2352 x 1568 pixels: 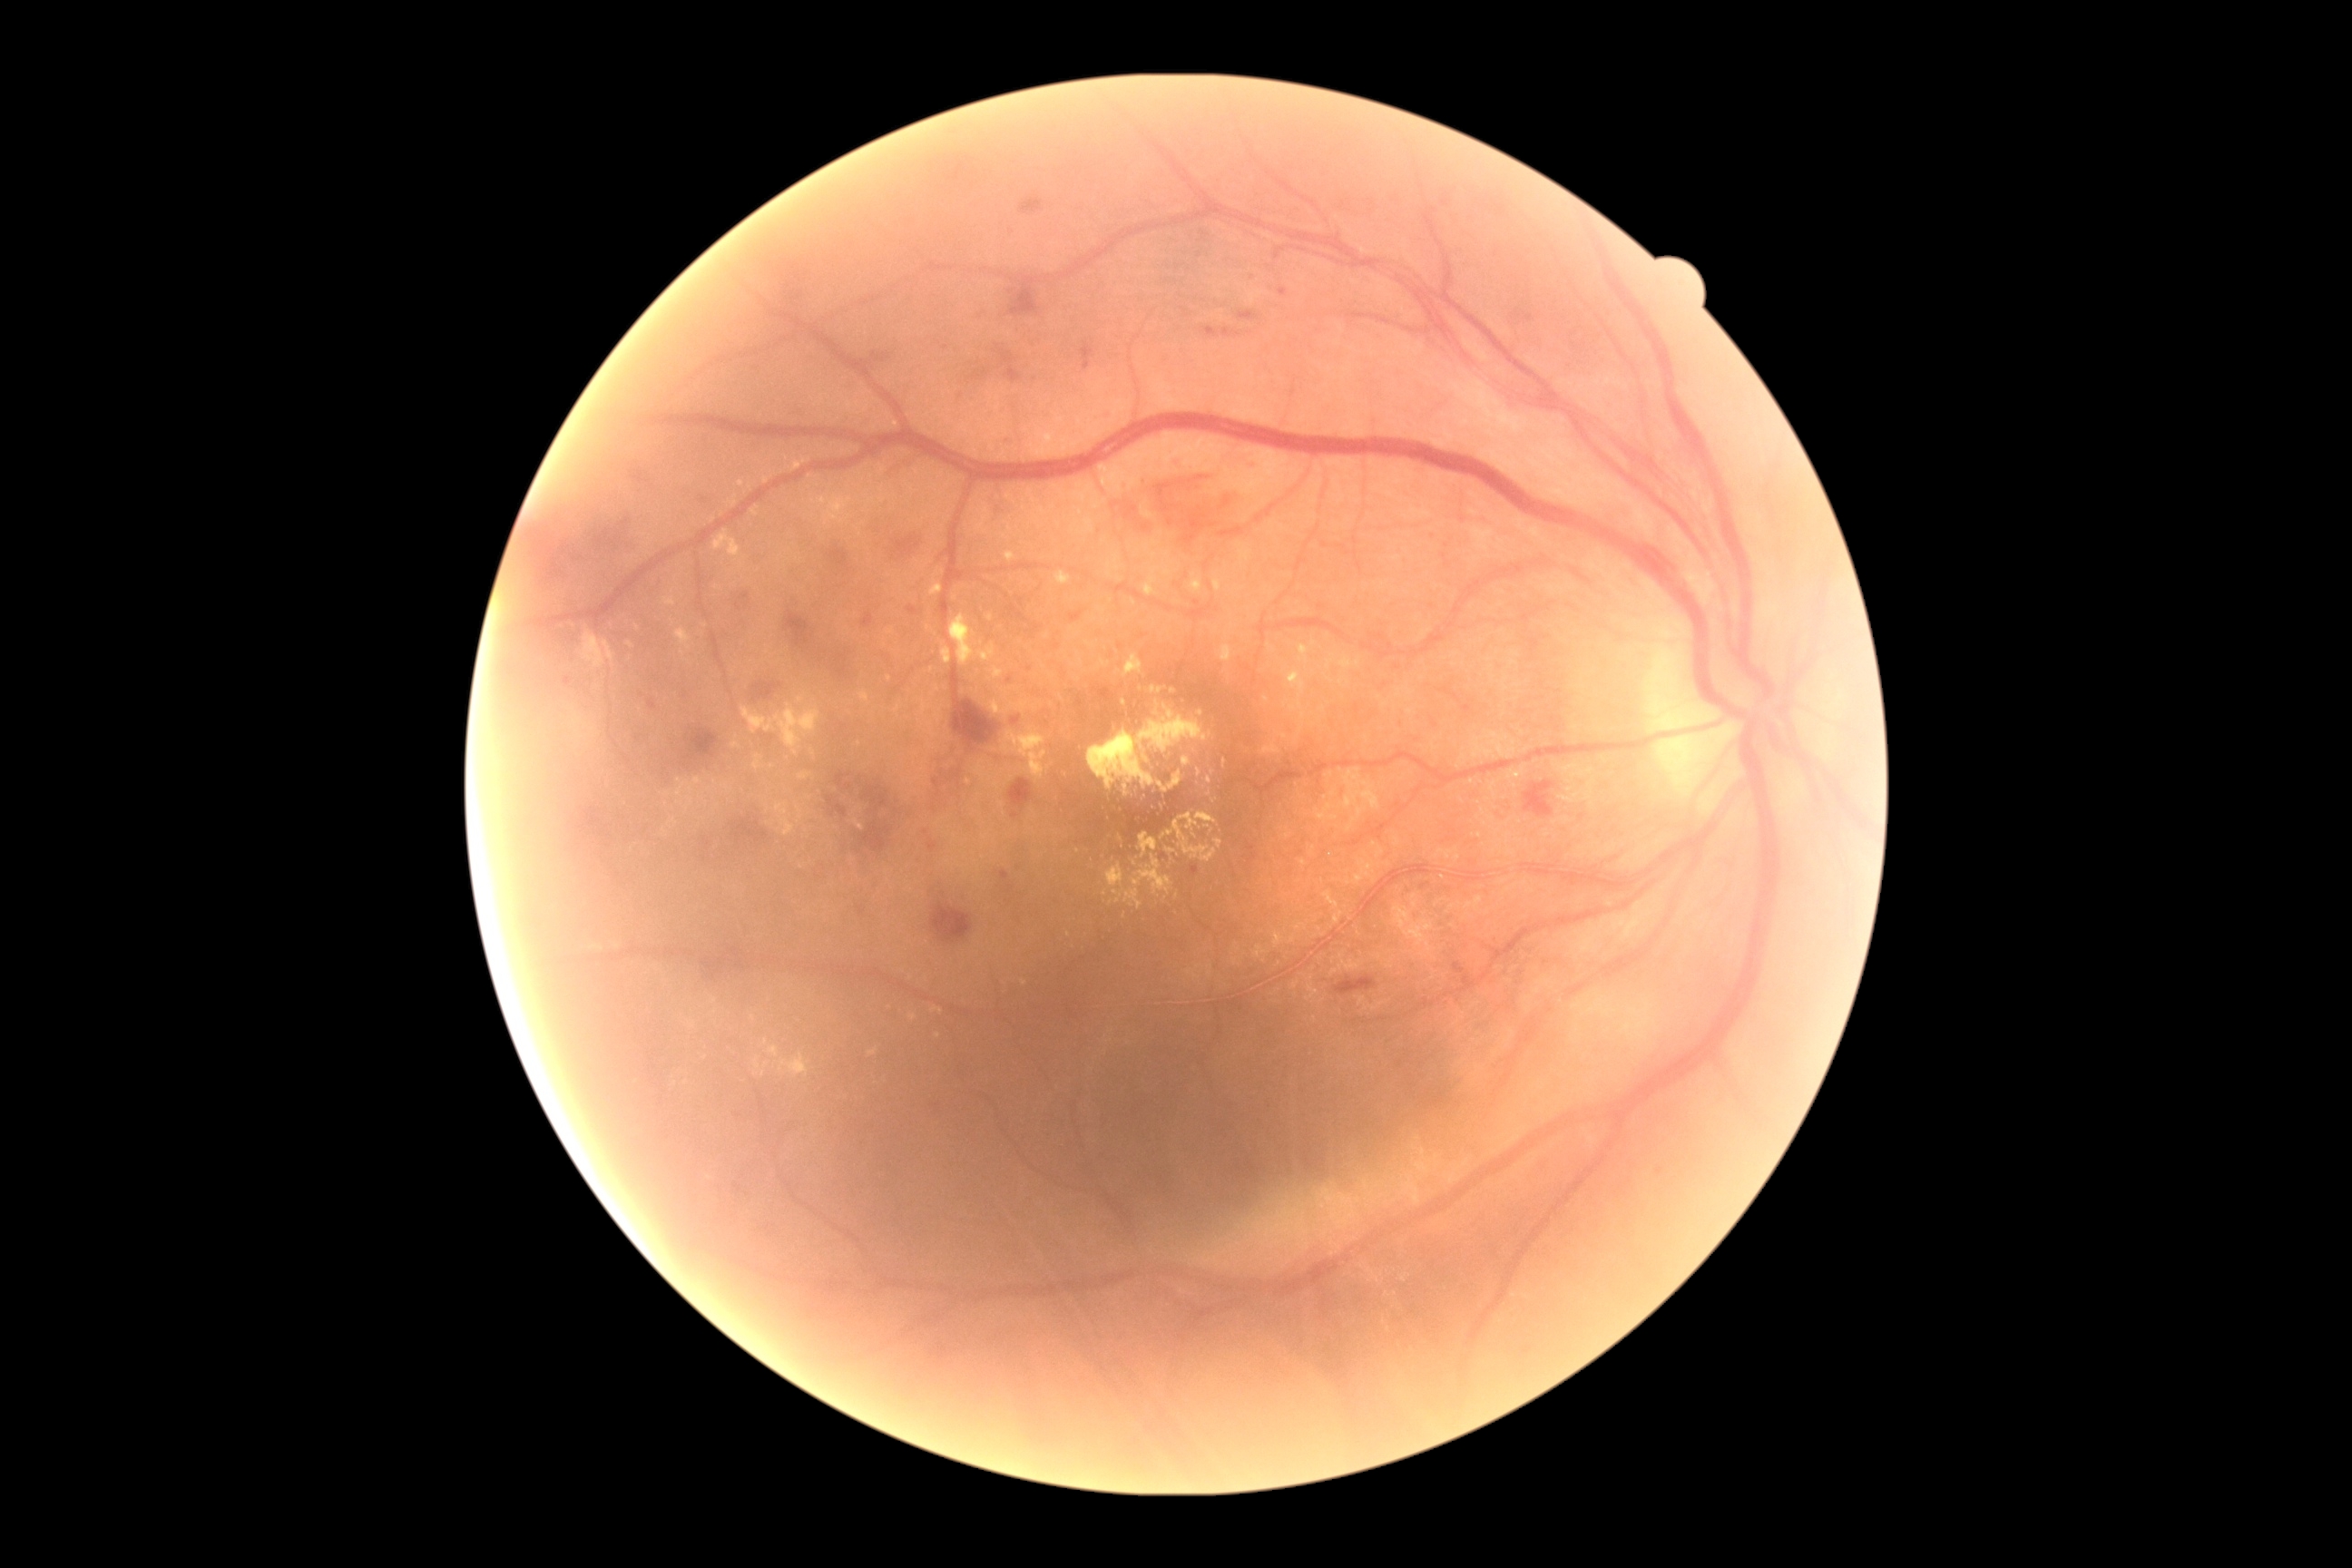 Diabetic retinopathy is grade 2 (moderate NPDR) — more than just microaneurysms but less than severe NPDR
Representative lesions:
hard exudates (partial): (left=1166, top=848, right=1177, bottom=856) | (left=1197, top=769, right=1202, bottom=778) | (left=930, top=582, right=943, bottom=596) | (left=676, top=627, right=692, bottom=651) | (left=721, top=783, right=729, bottom=790) | (left=1404, top=888, right=1436, bottom=939) | (left=865, top=495, right=876, bottom=507) | (left=1190, top=574, right=1202, bottom=593) | (left=1324, top=892, right=1342, bottom=926) | (left=1199, top=710, right=1204, bottom=718) | (left=1077, top=654, right=1084, bottom=669)
Smaller hard exudates around <pt>896,424</pt> | <pt>750,486</pt> | <pt>1077,852</pt> | <pt>1120,838</pt> | <pt>1266,700</pt> | <pt>1296,614</pt> | <pt>716,1012</pt>